Image size 1240x1240; pediatric wide-field fundus photograph — 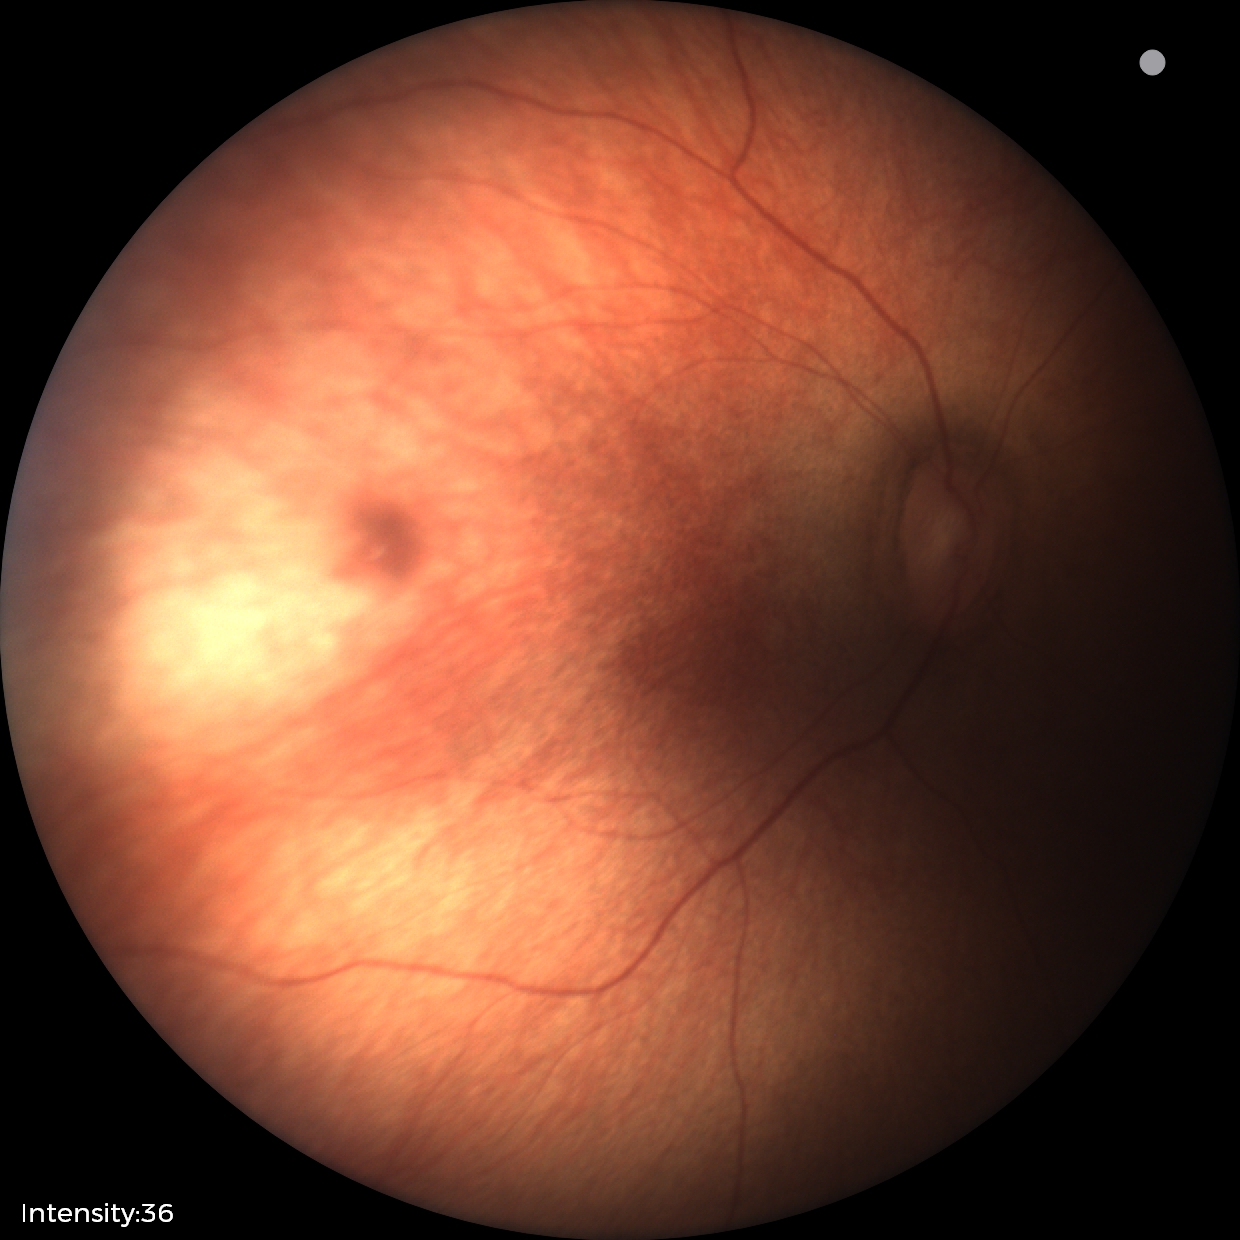

Screening examination diagnosed as physiological.